CFP:
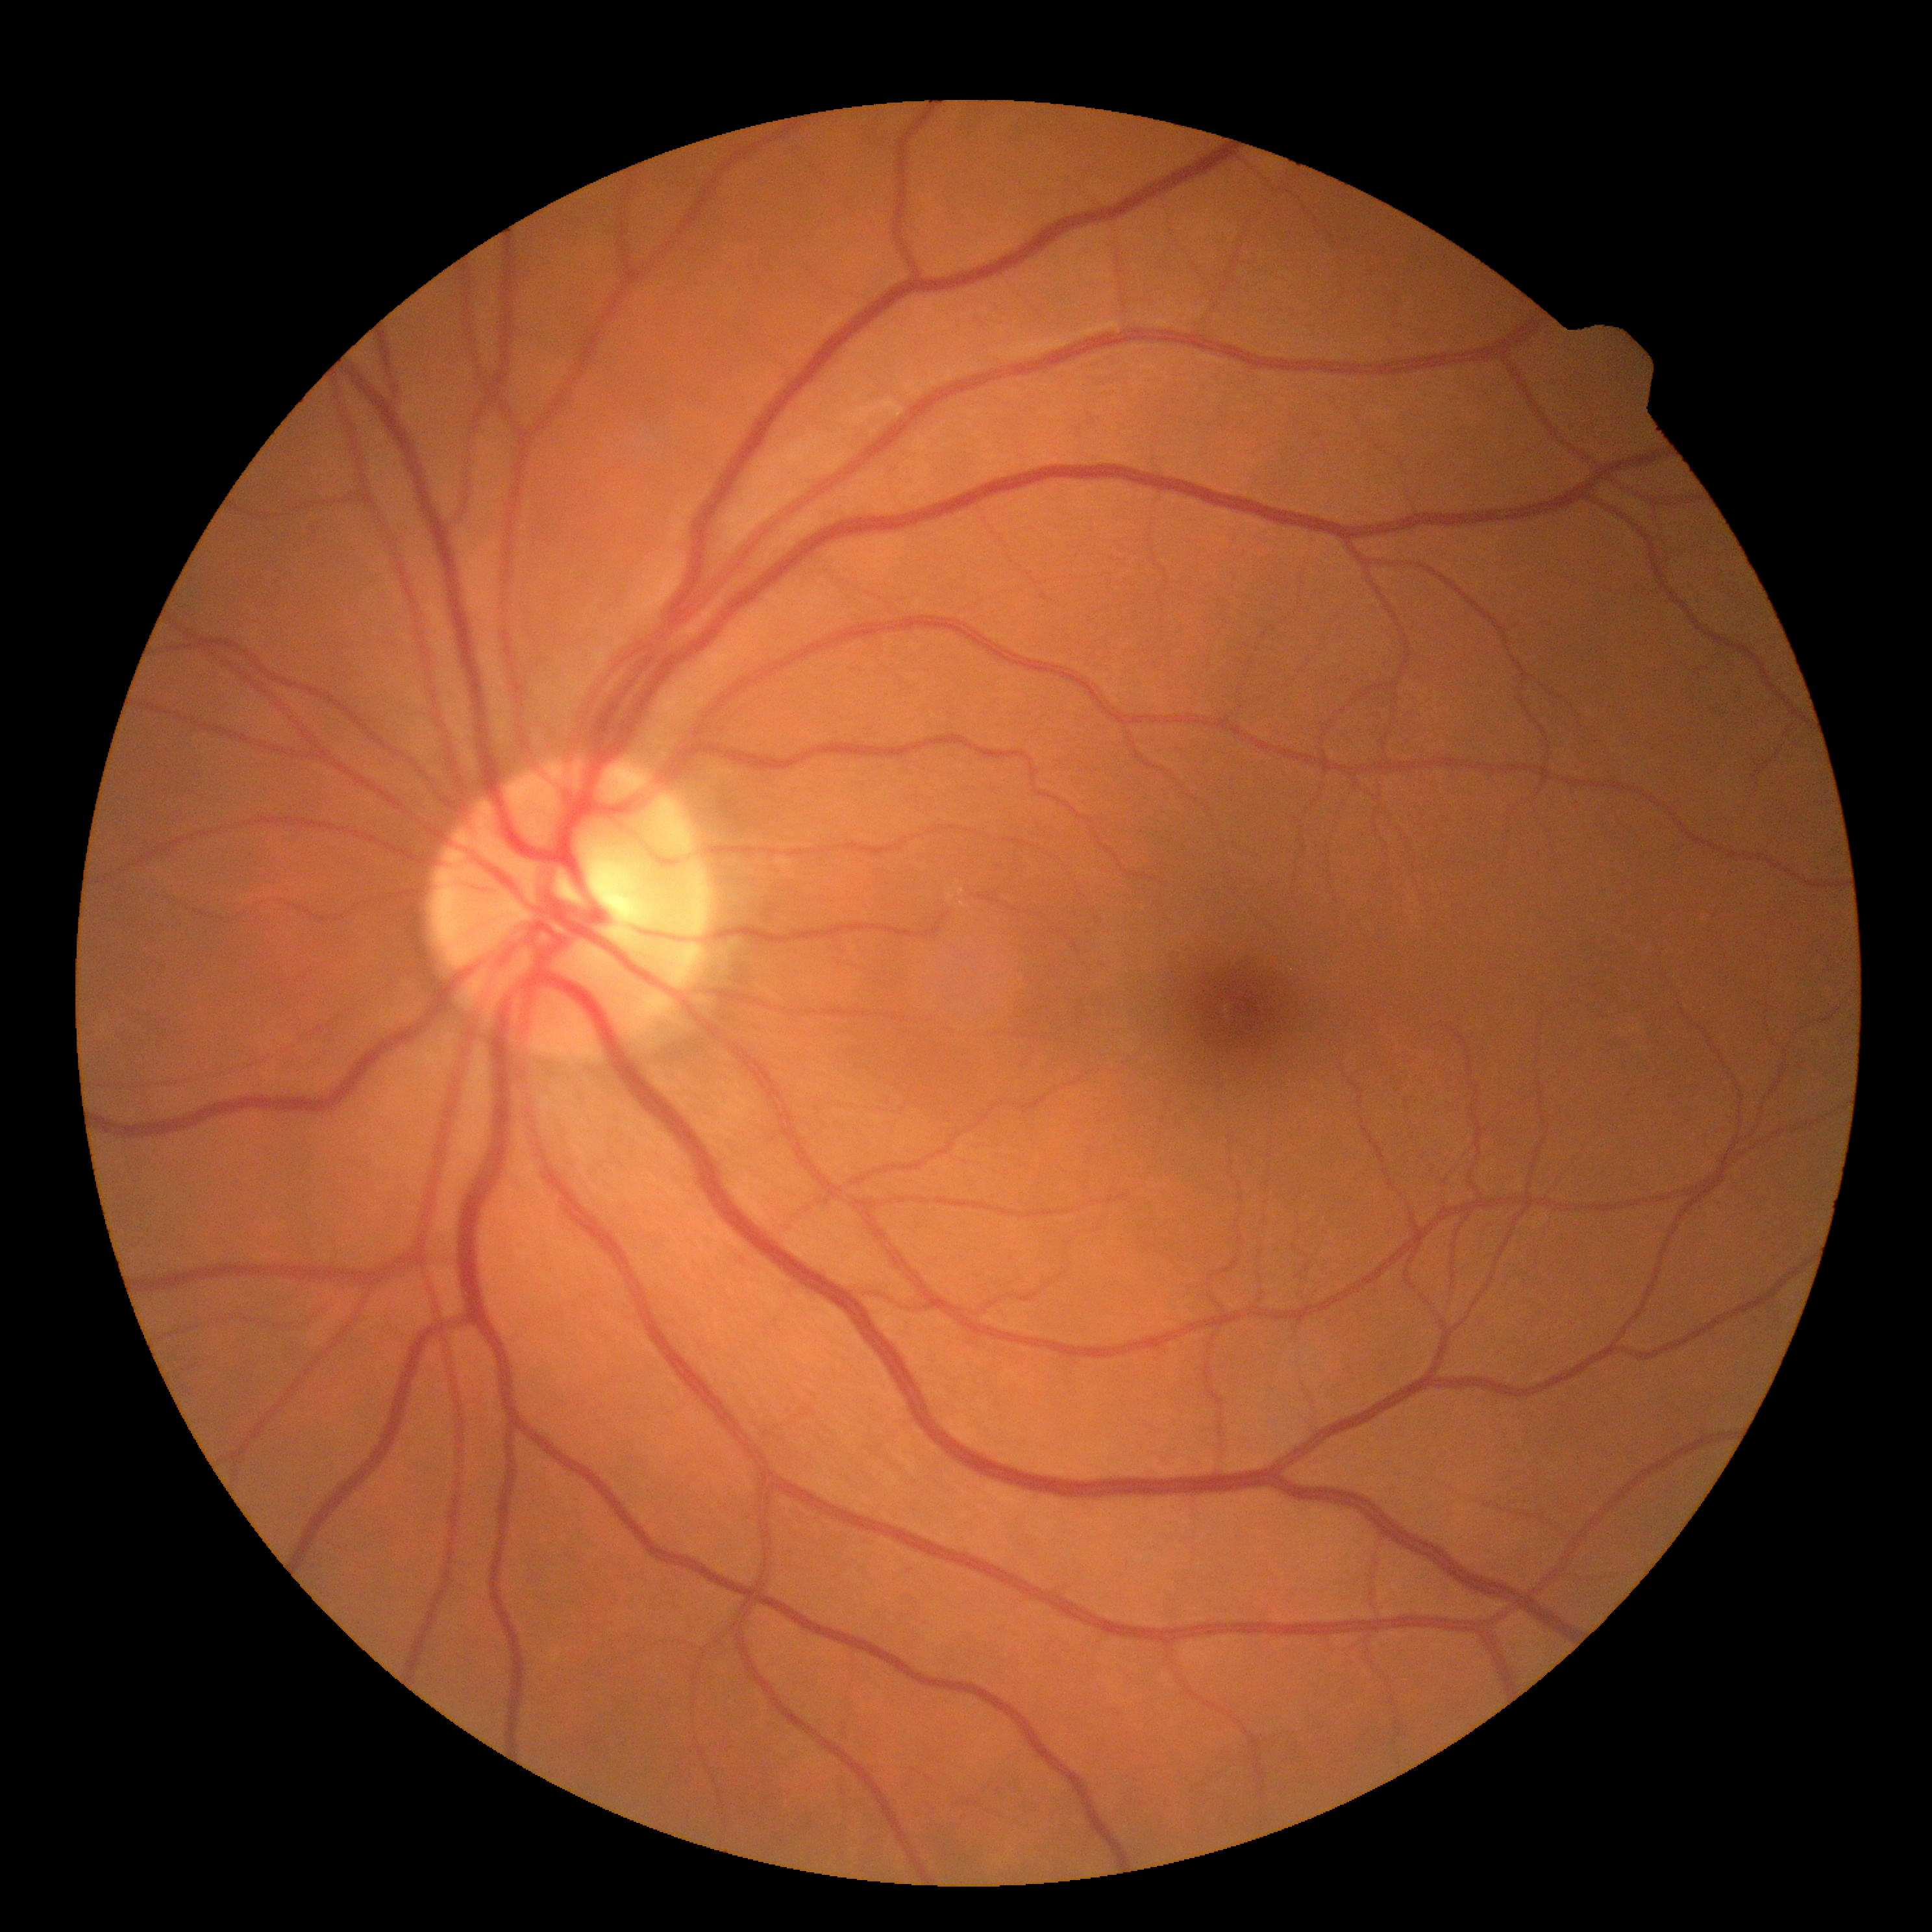

Diabetic retinopathy severity: 0.
No signs of diabetic retinopathy.